NIDEK AFC-230
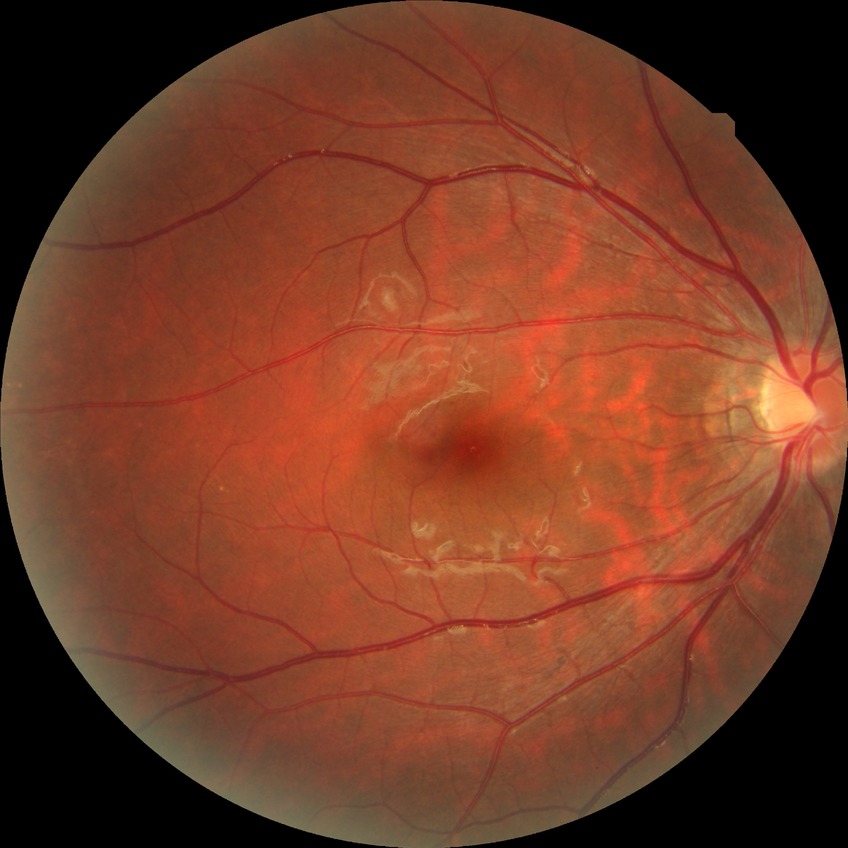

Annotations:
• retinopathy grade: no diabetic retinopathy